100° field of view (Phoenix ICON) · 1240x1240 · wide-field contact fundus photograph of an infant.
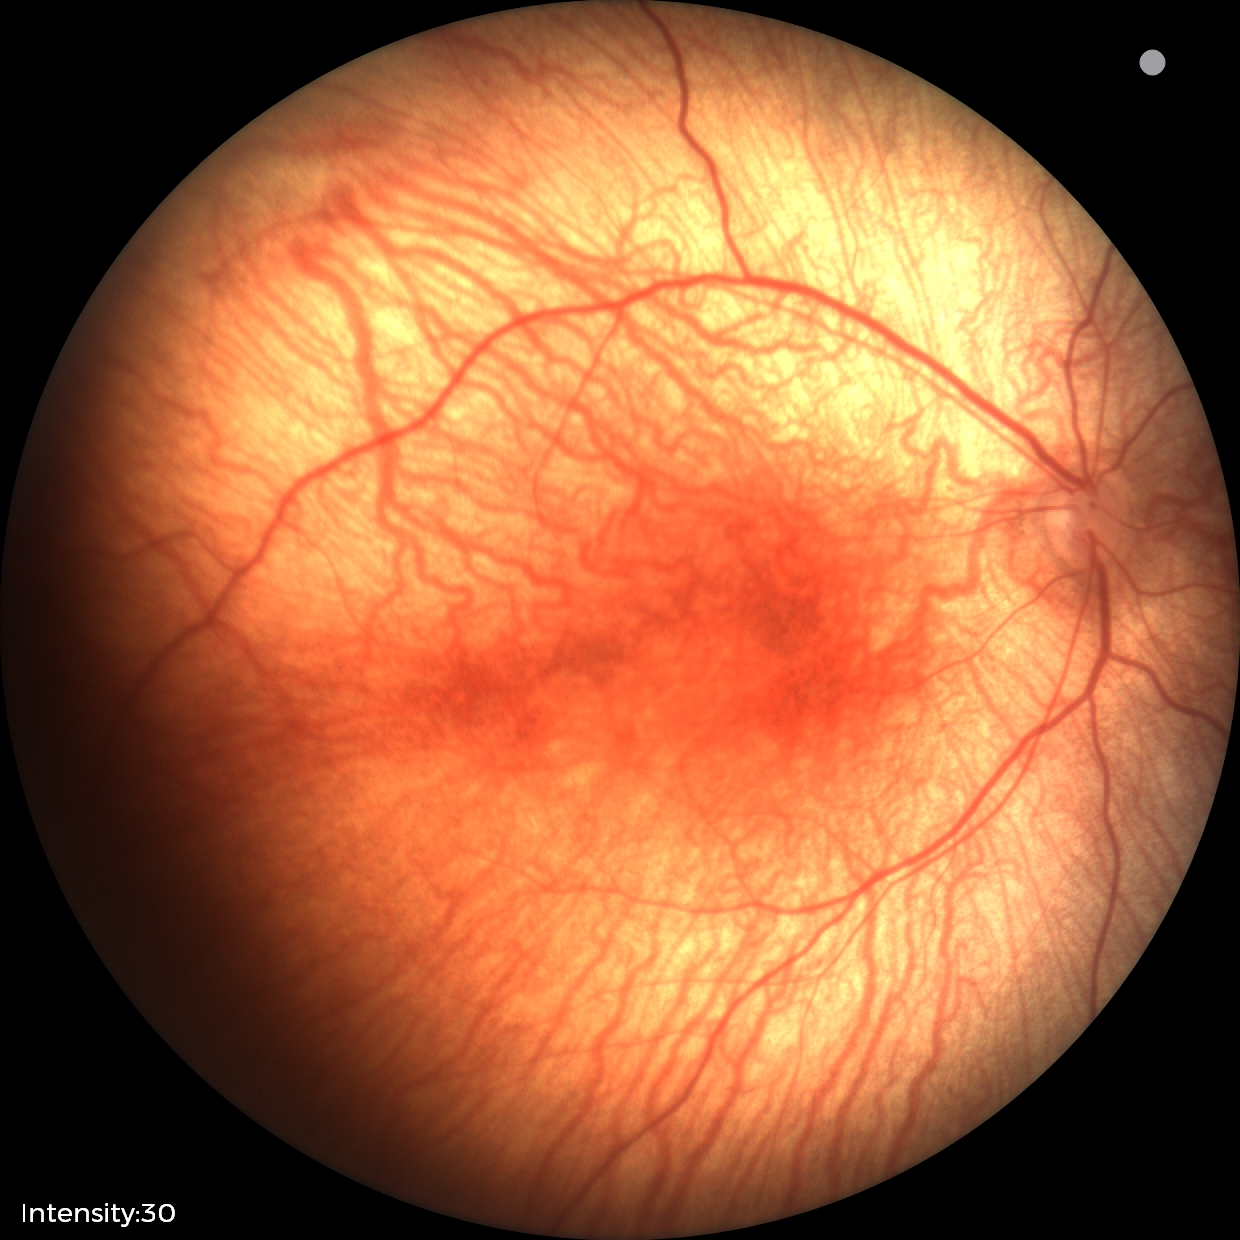
No retinal pathology identified on screening.